Davis DR grading: 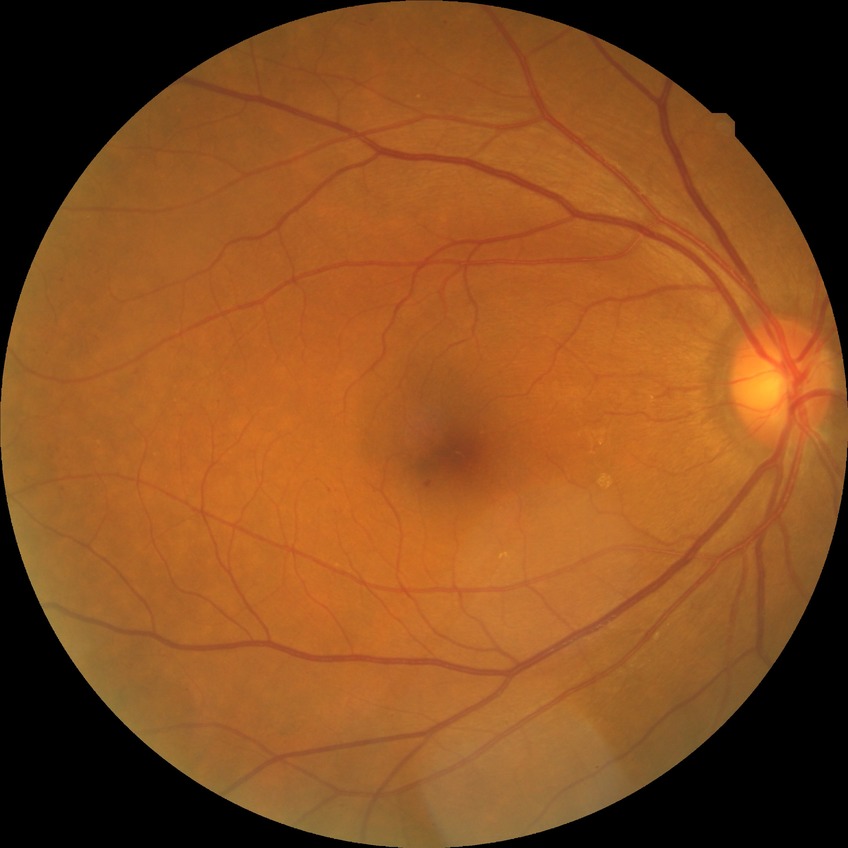
  proliferative_class: non-proliferative diabetic retinopathy
  davis_grade: simple diabetic retinopathy (SDR)